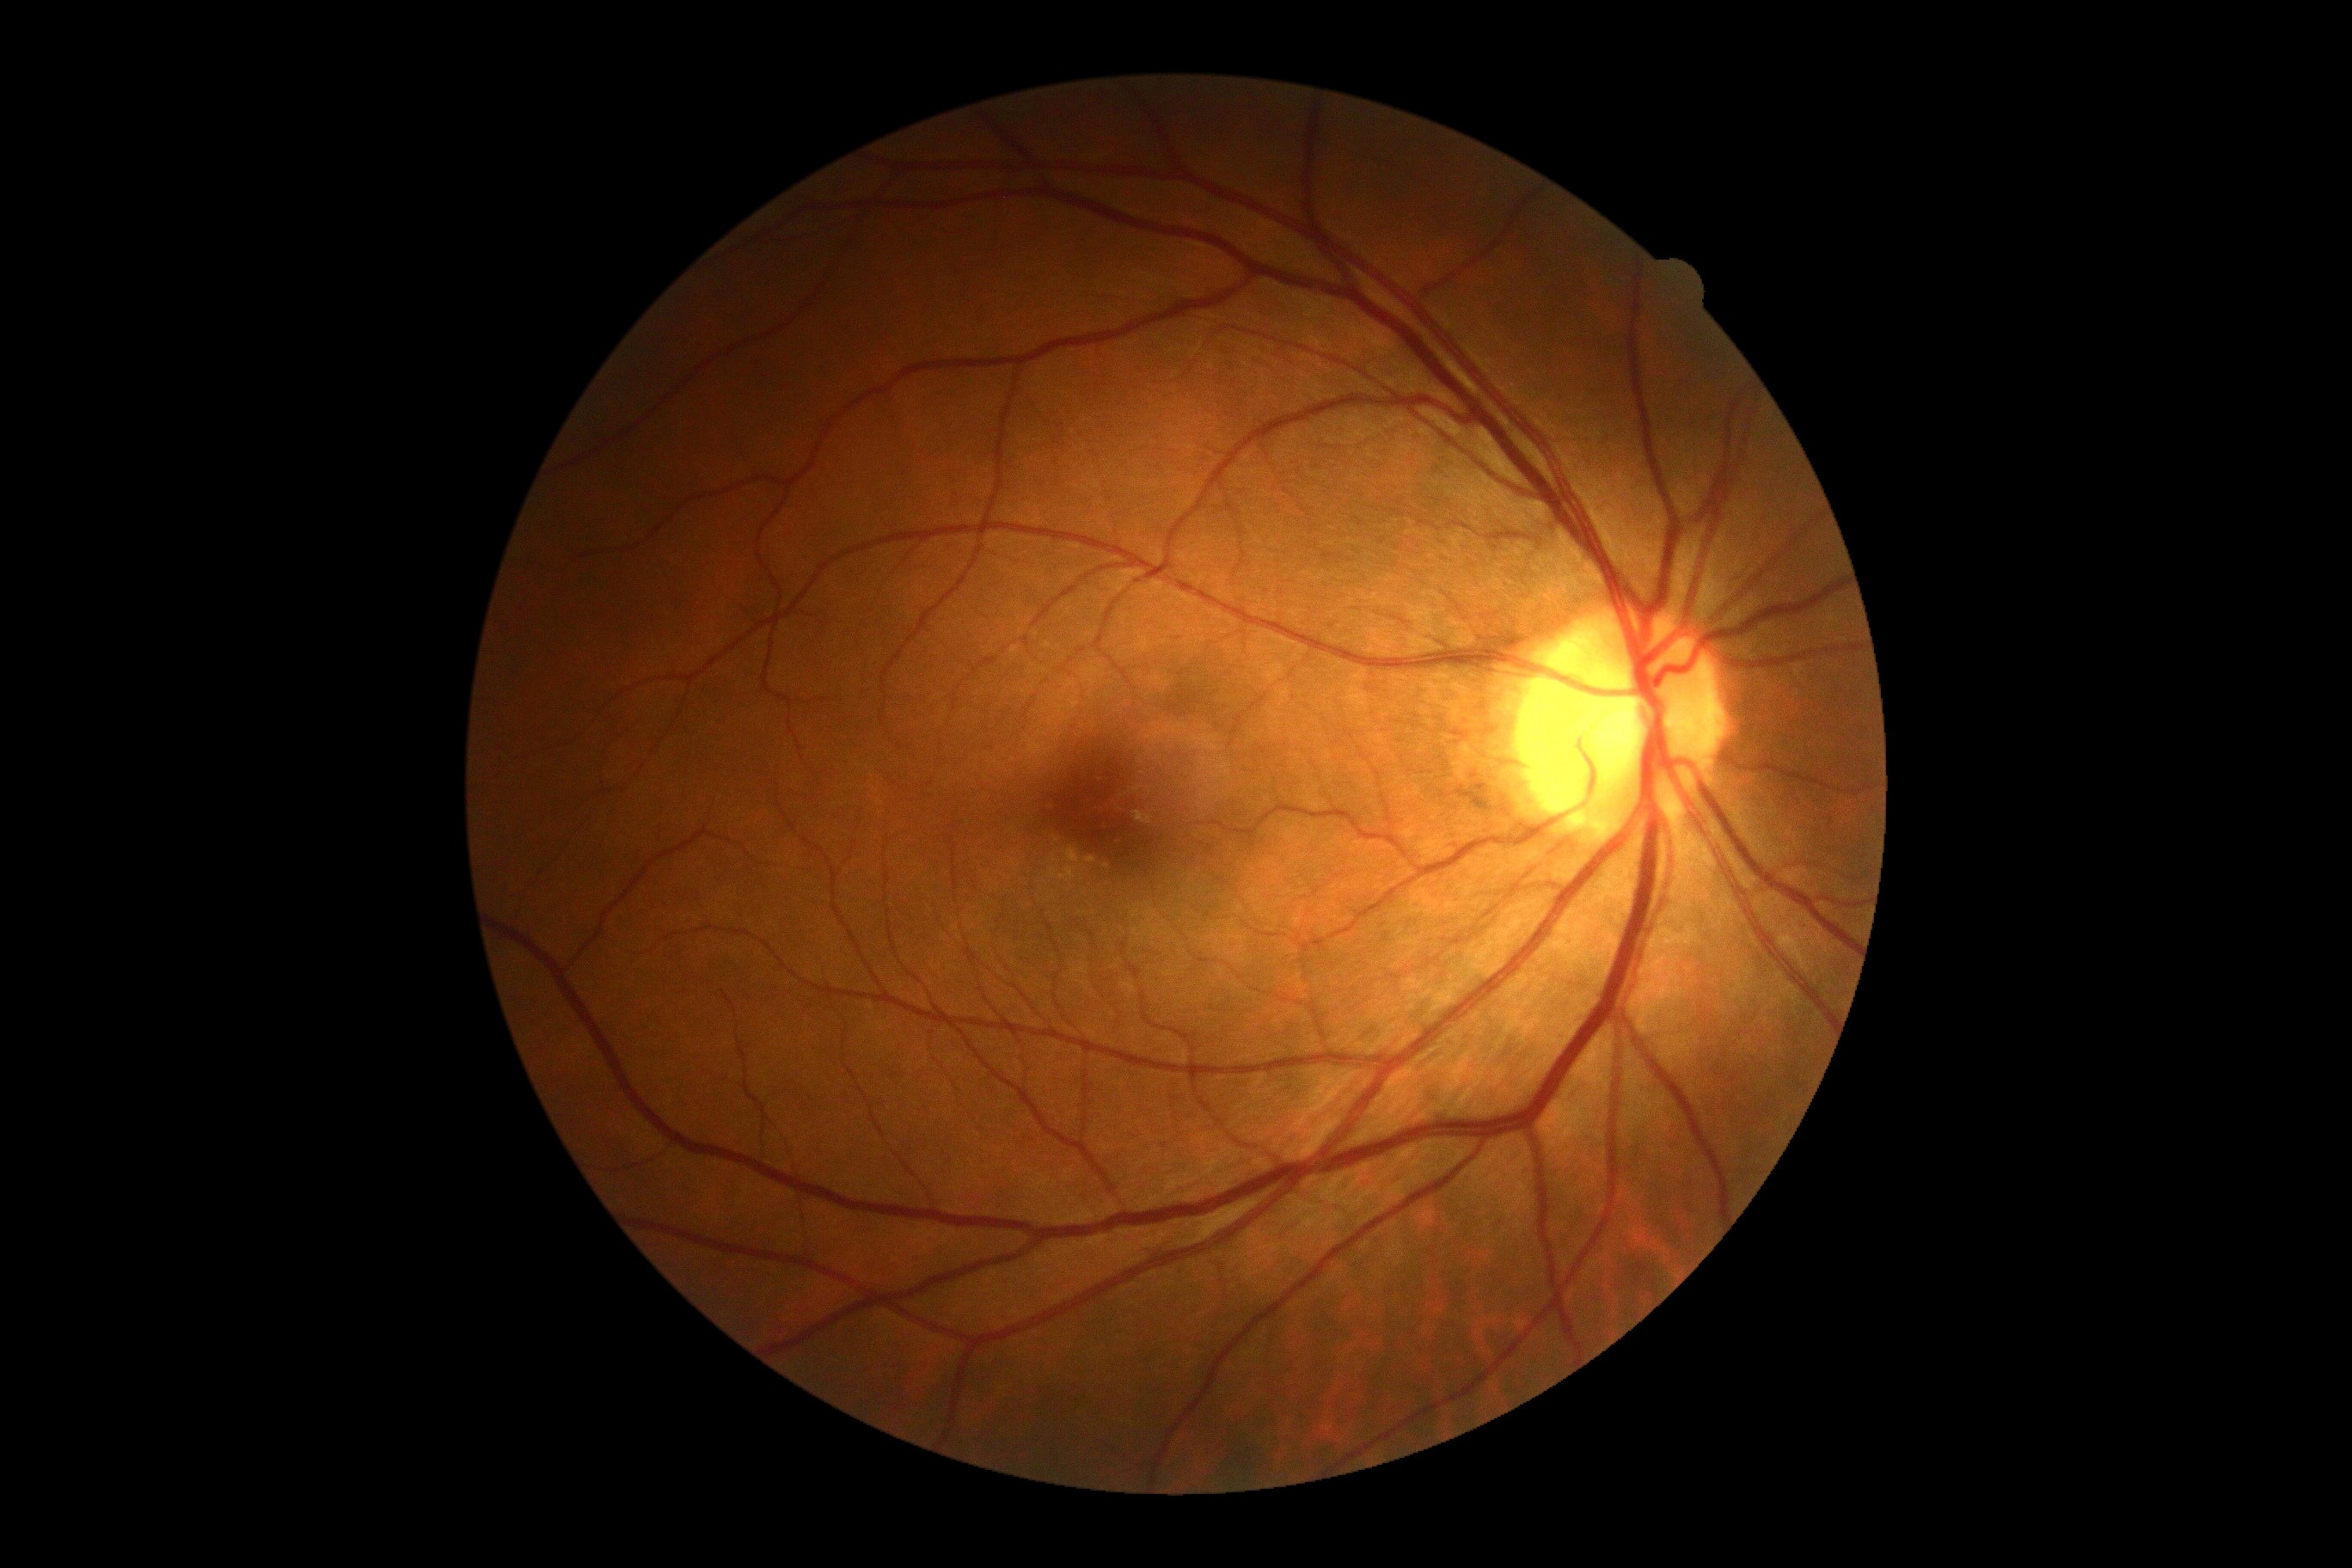 No signs of diabetic retinopathy. DR is 0.